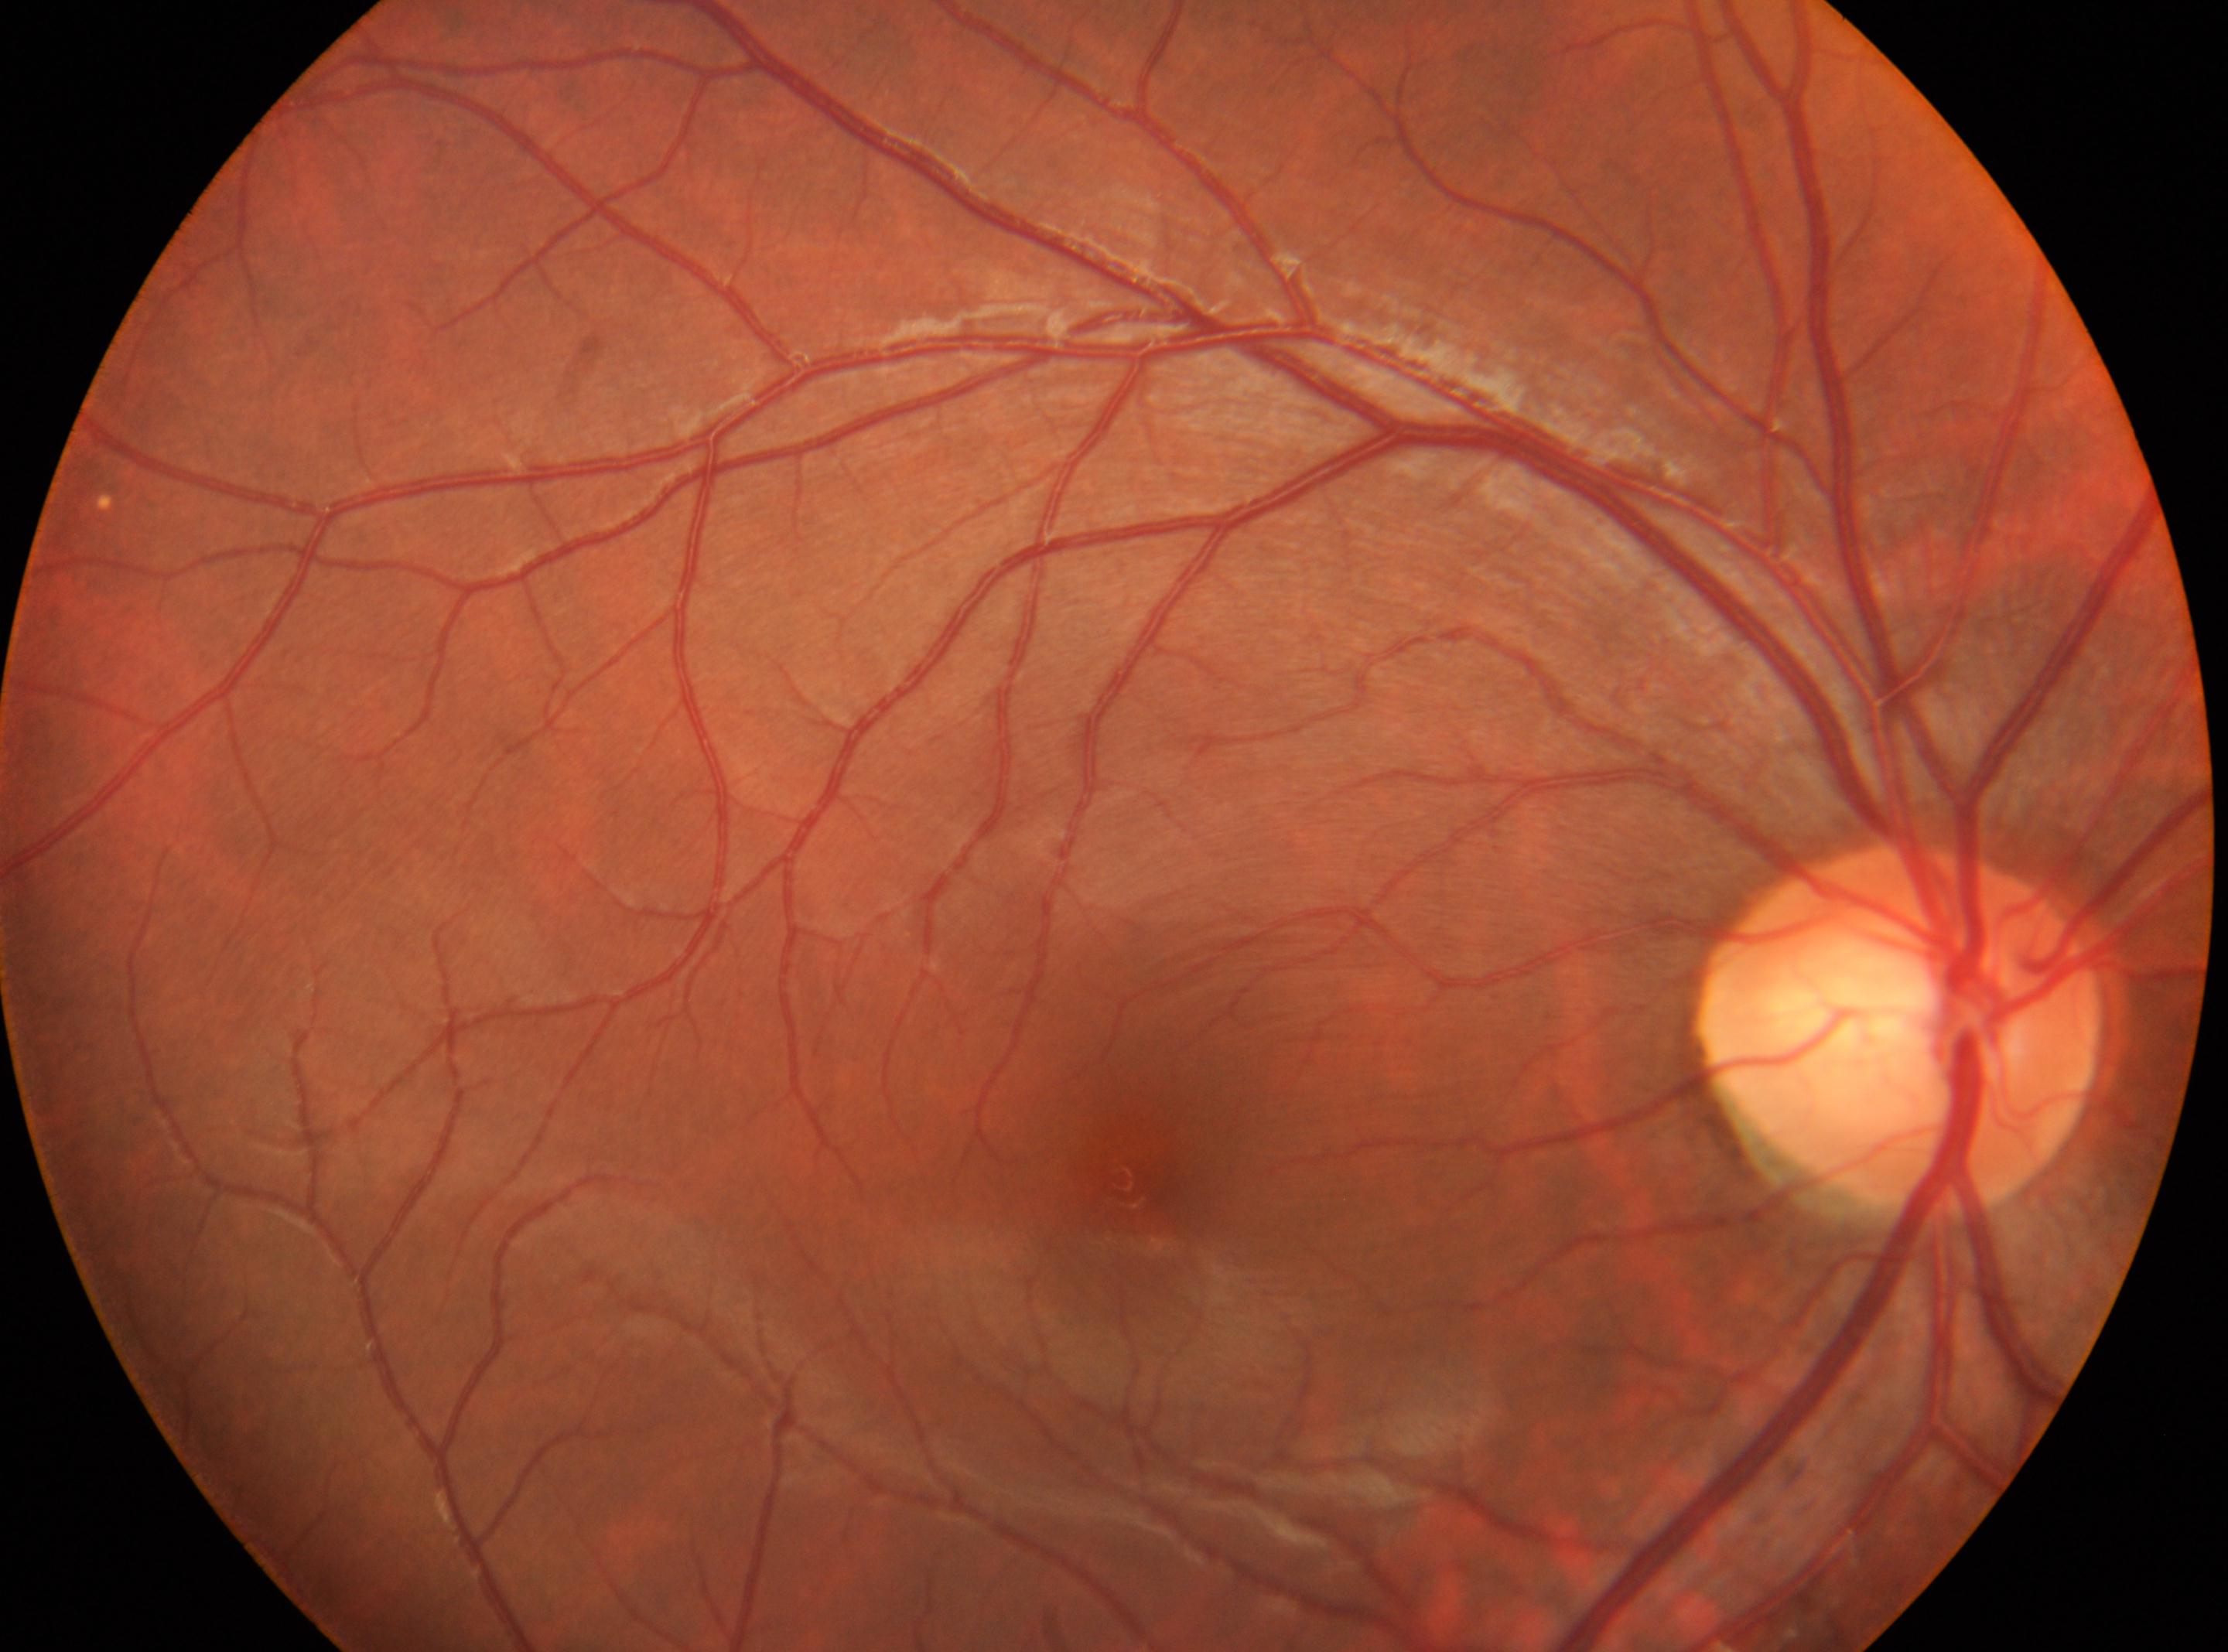

The disc center is at (x: 1899, y: 1029). No signs of diabetic retinopathy. Eye: right. Fovea center: (x: 1122, y: 1179). DR grade: 0.